Wide-field contact fundus photograph of an infant:
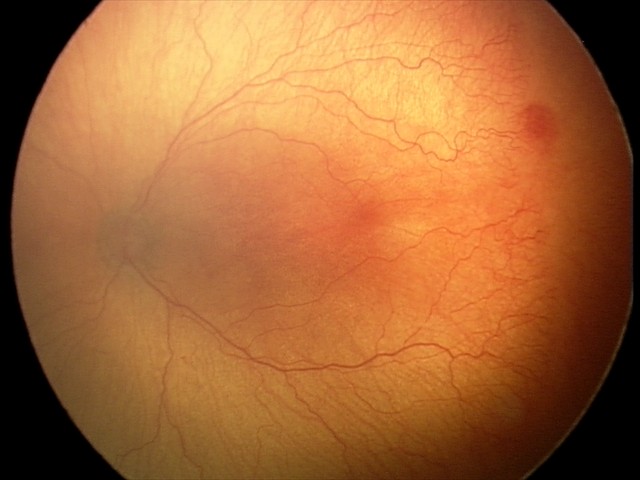

With plus disease.
Examination diagnosed as aggressive retinopathy of prematurity.